2352 x 1568 pixels — 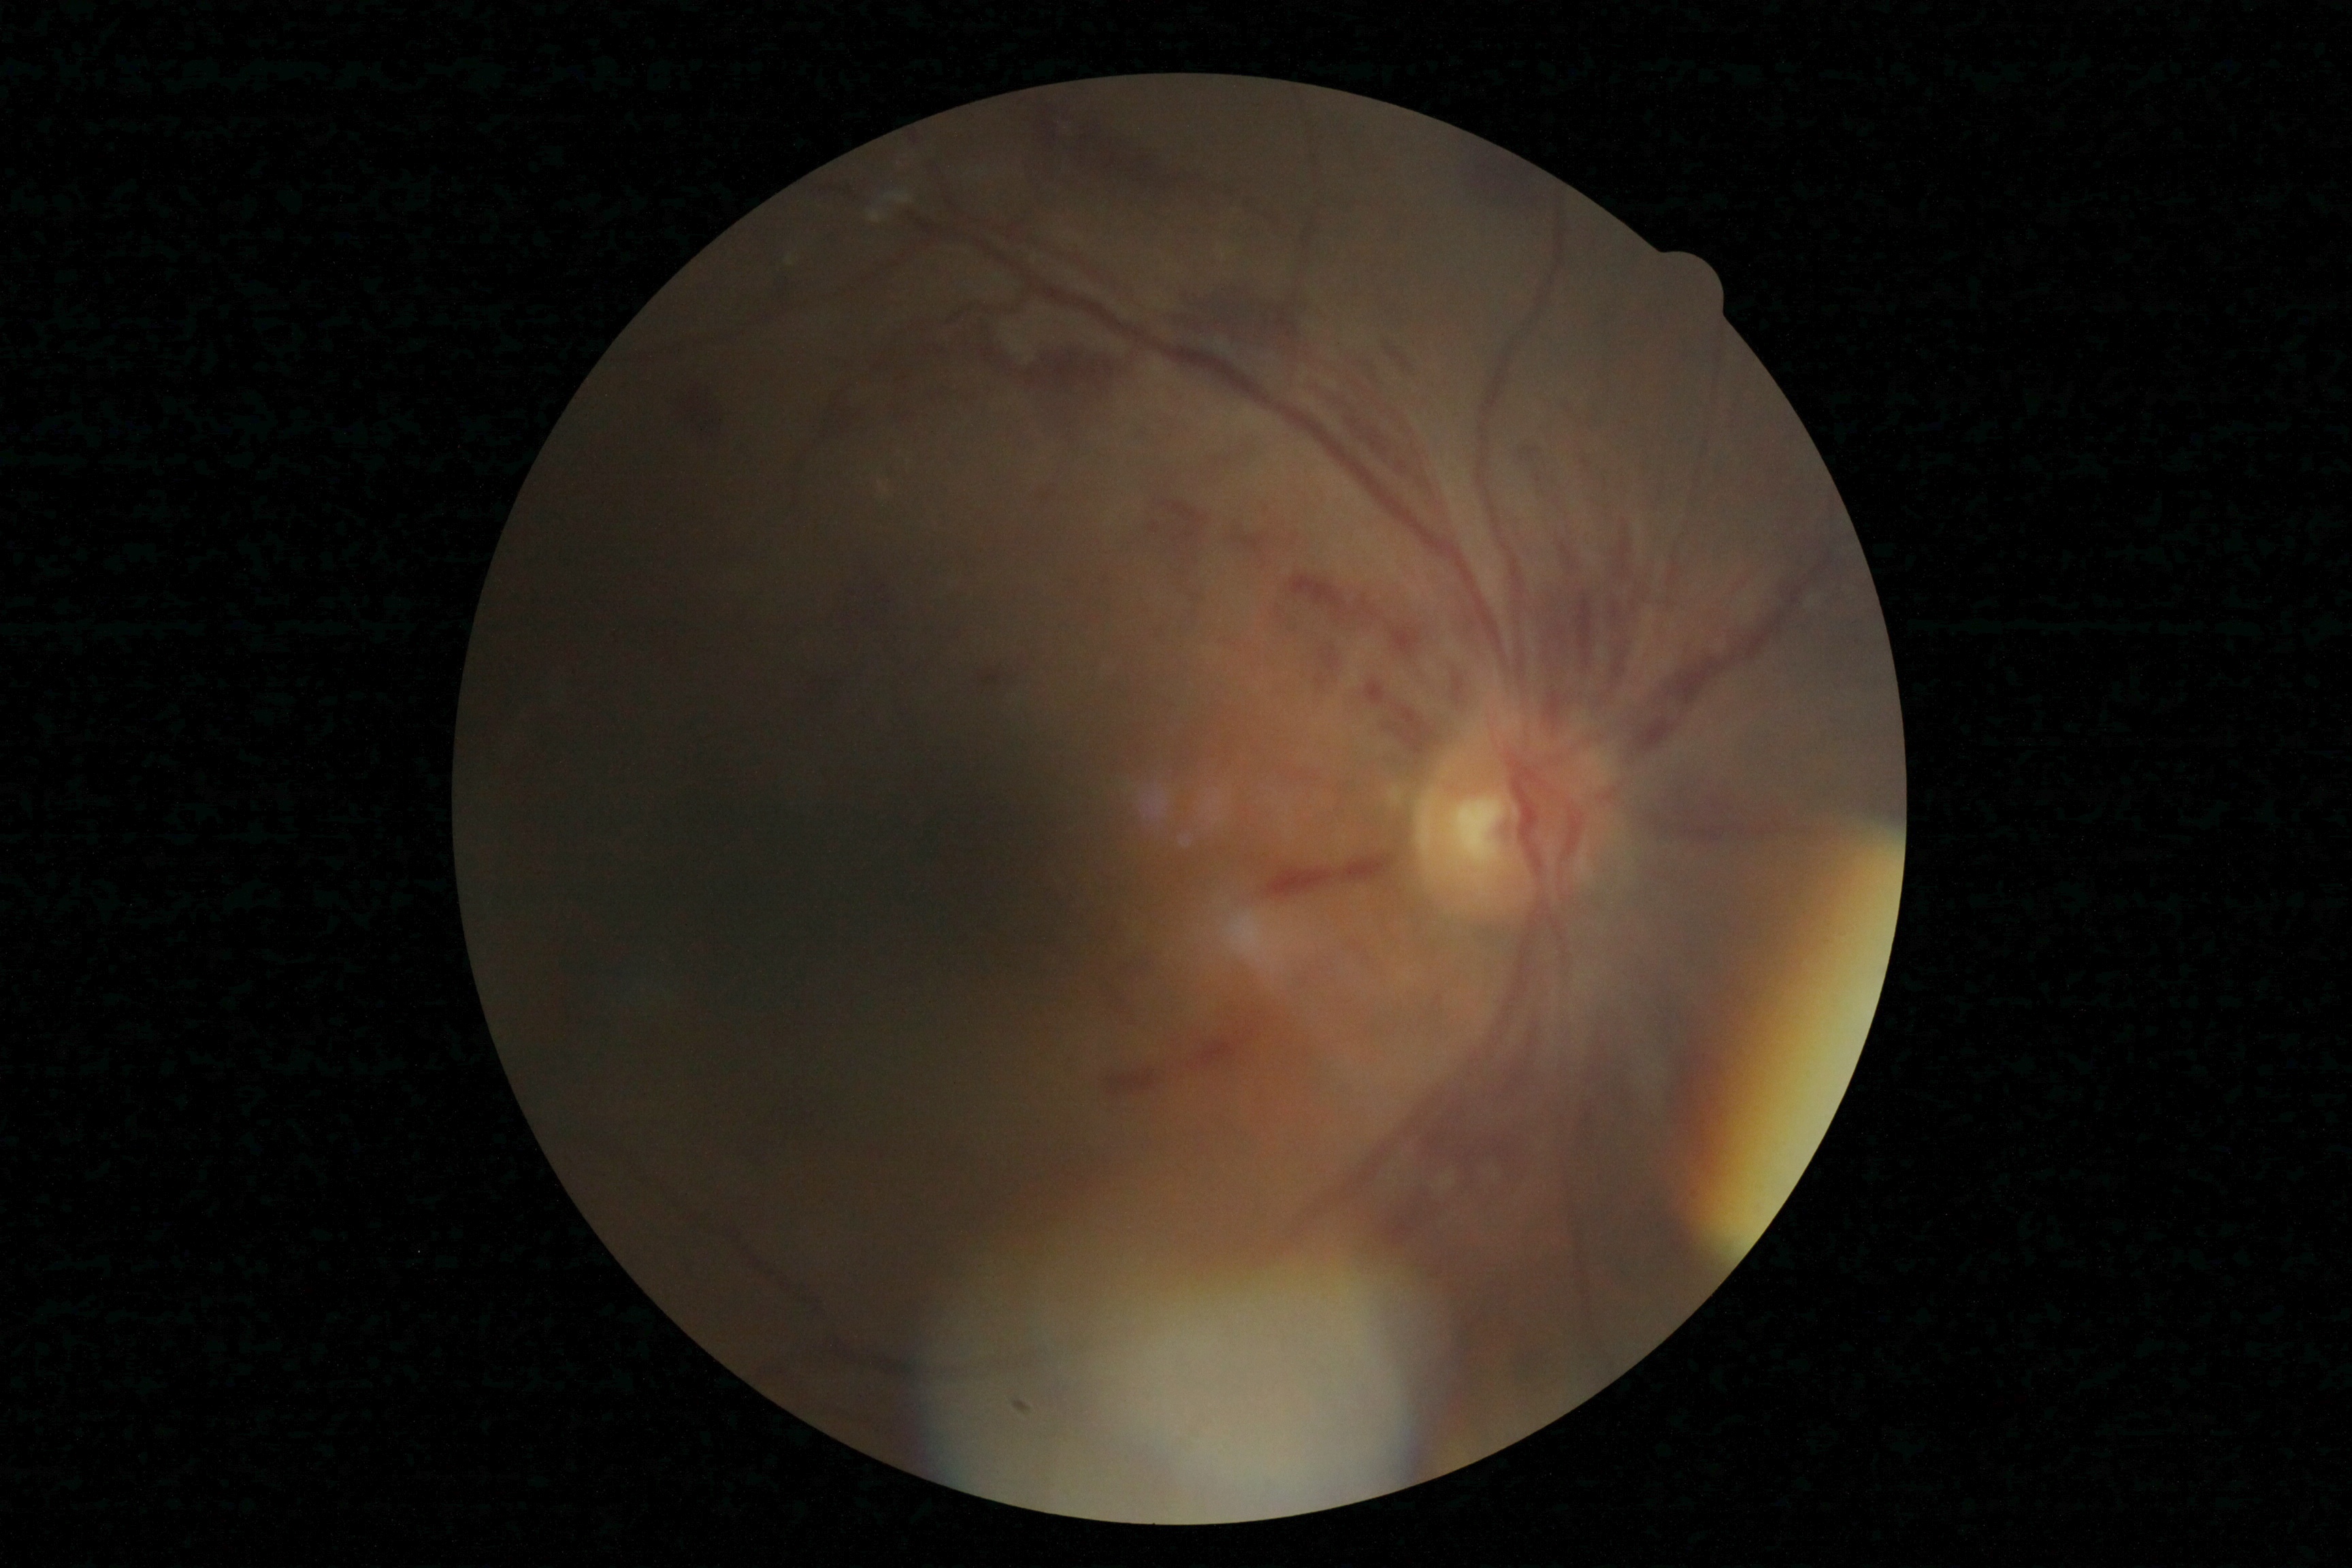
{"dr_grade": "2 — more than just microaneurysms but less than severe NPDR"}